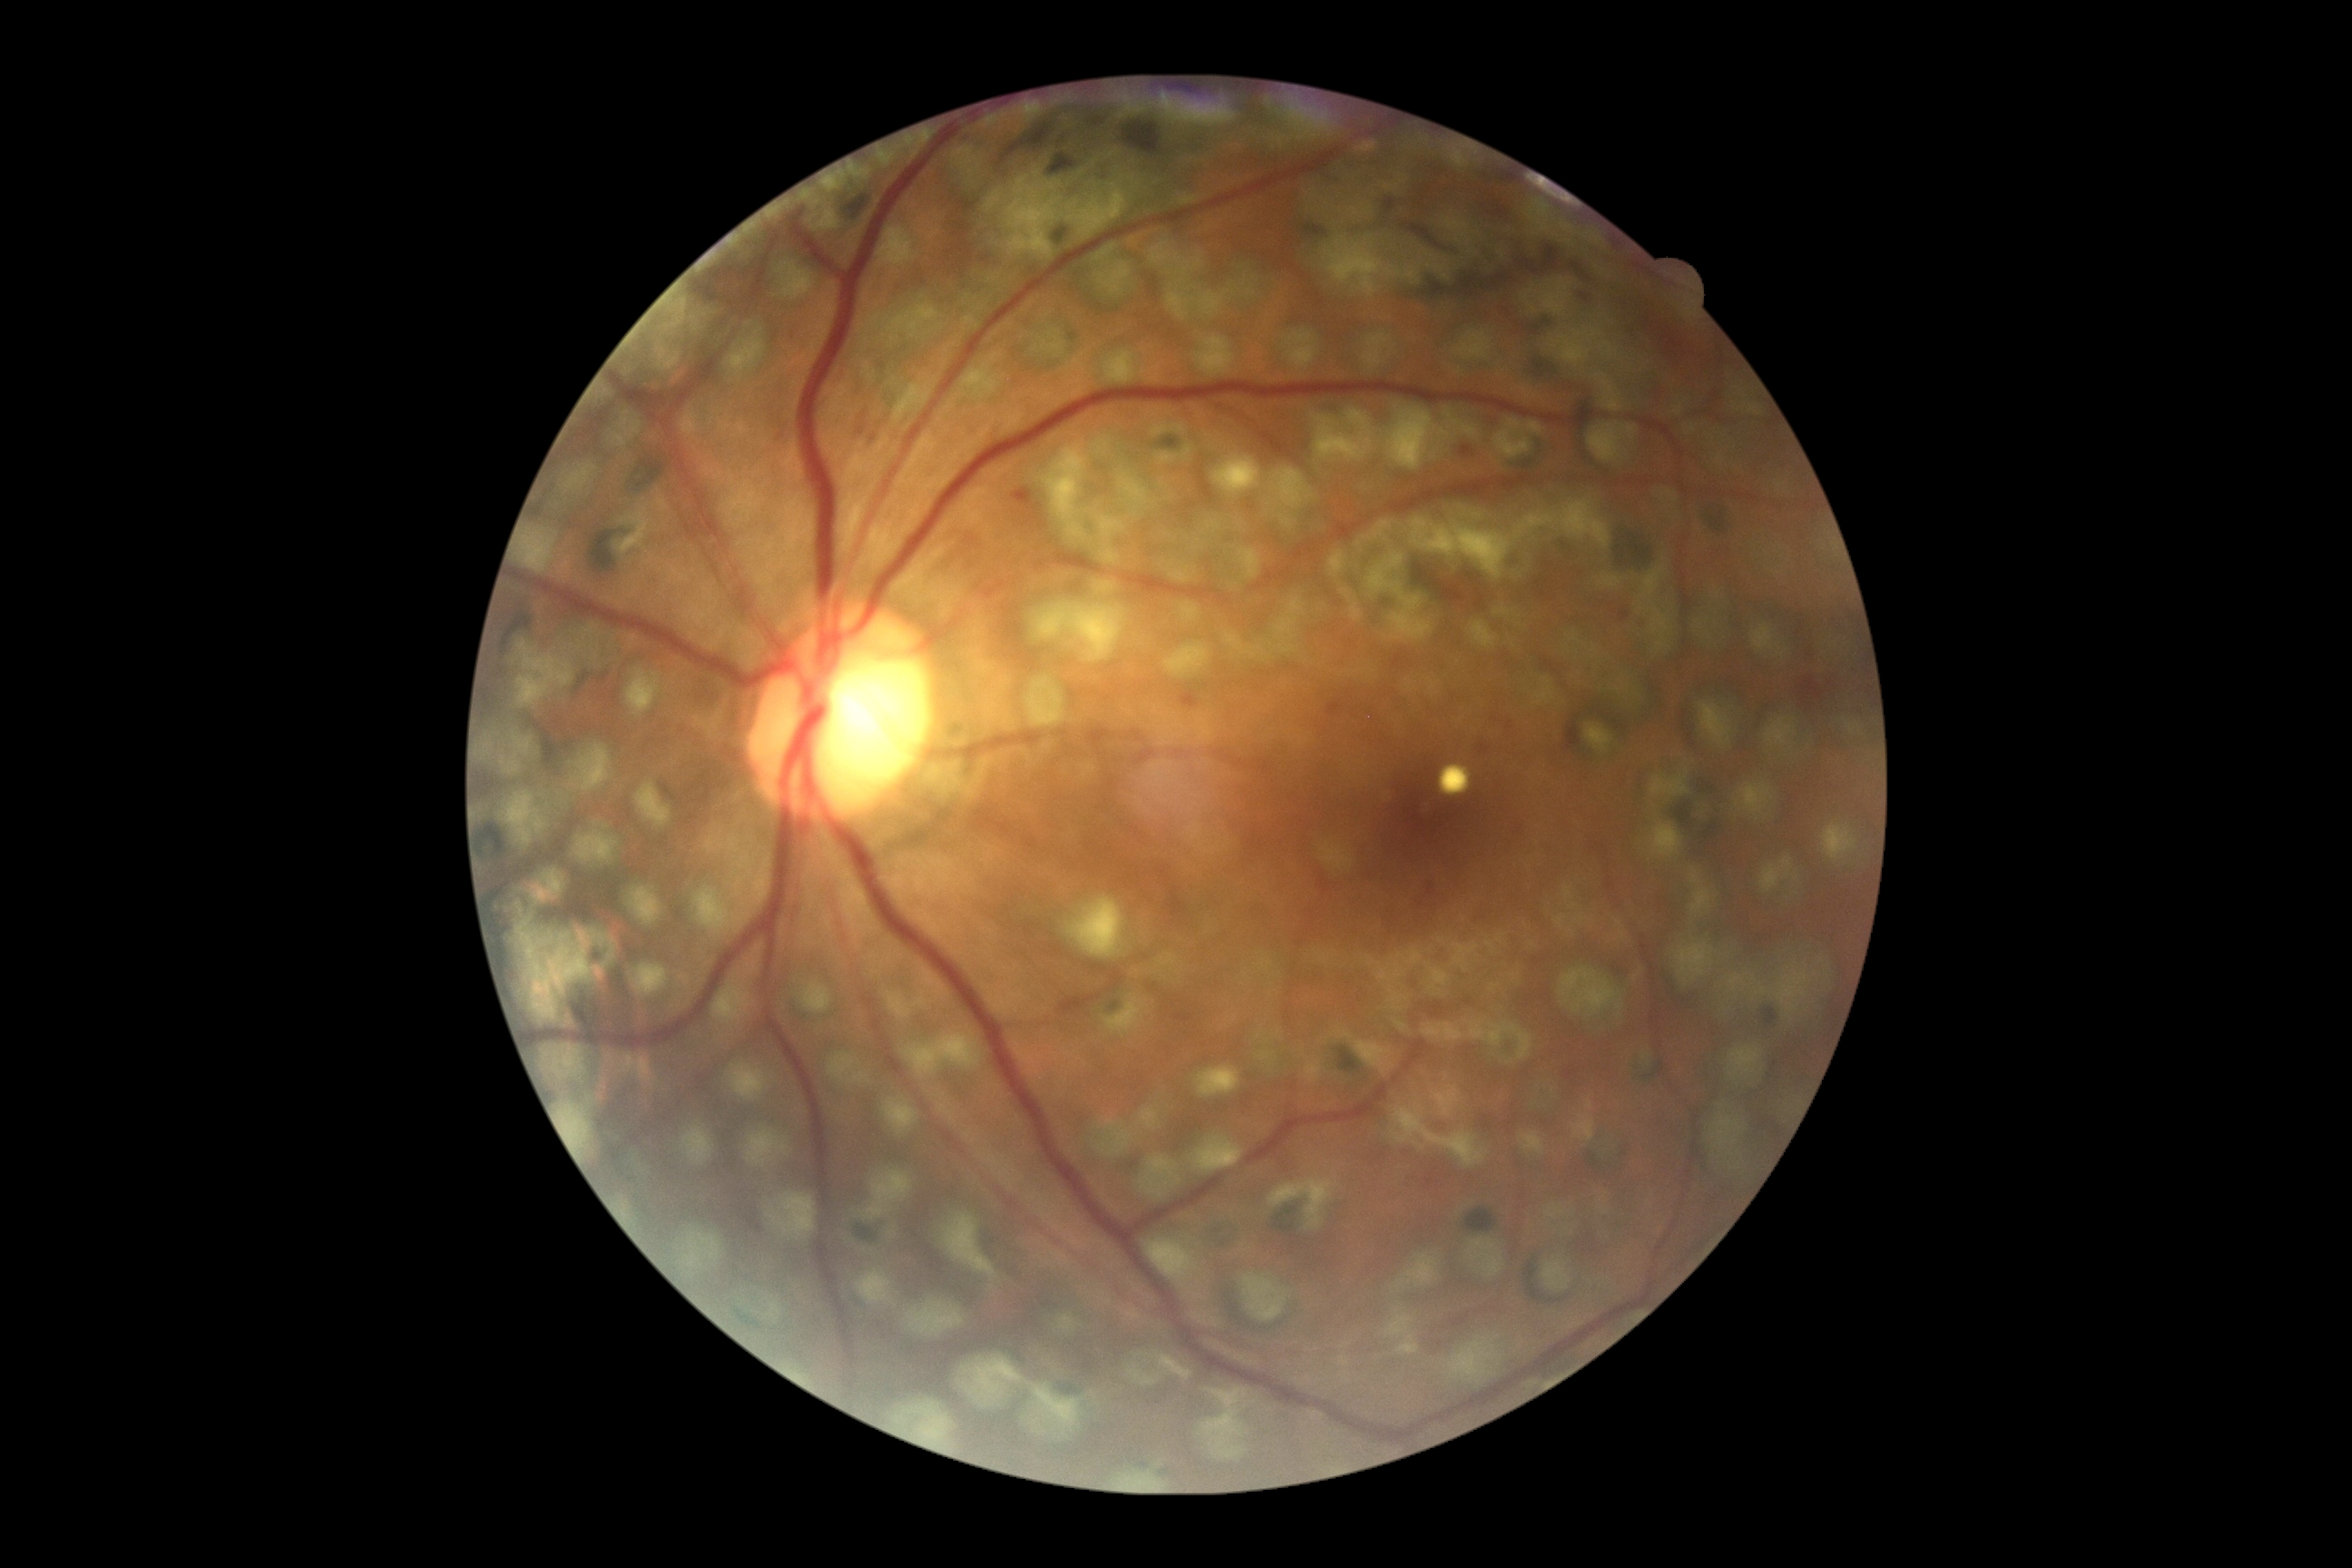 DR grade: moderate NPDR (2).
DR class: non-proliferative diabetic retinopathy.